Phoenix ICON, 100° FOV · wide-field contact fundus photograph of an infant · 1240x1240:
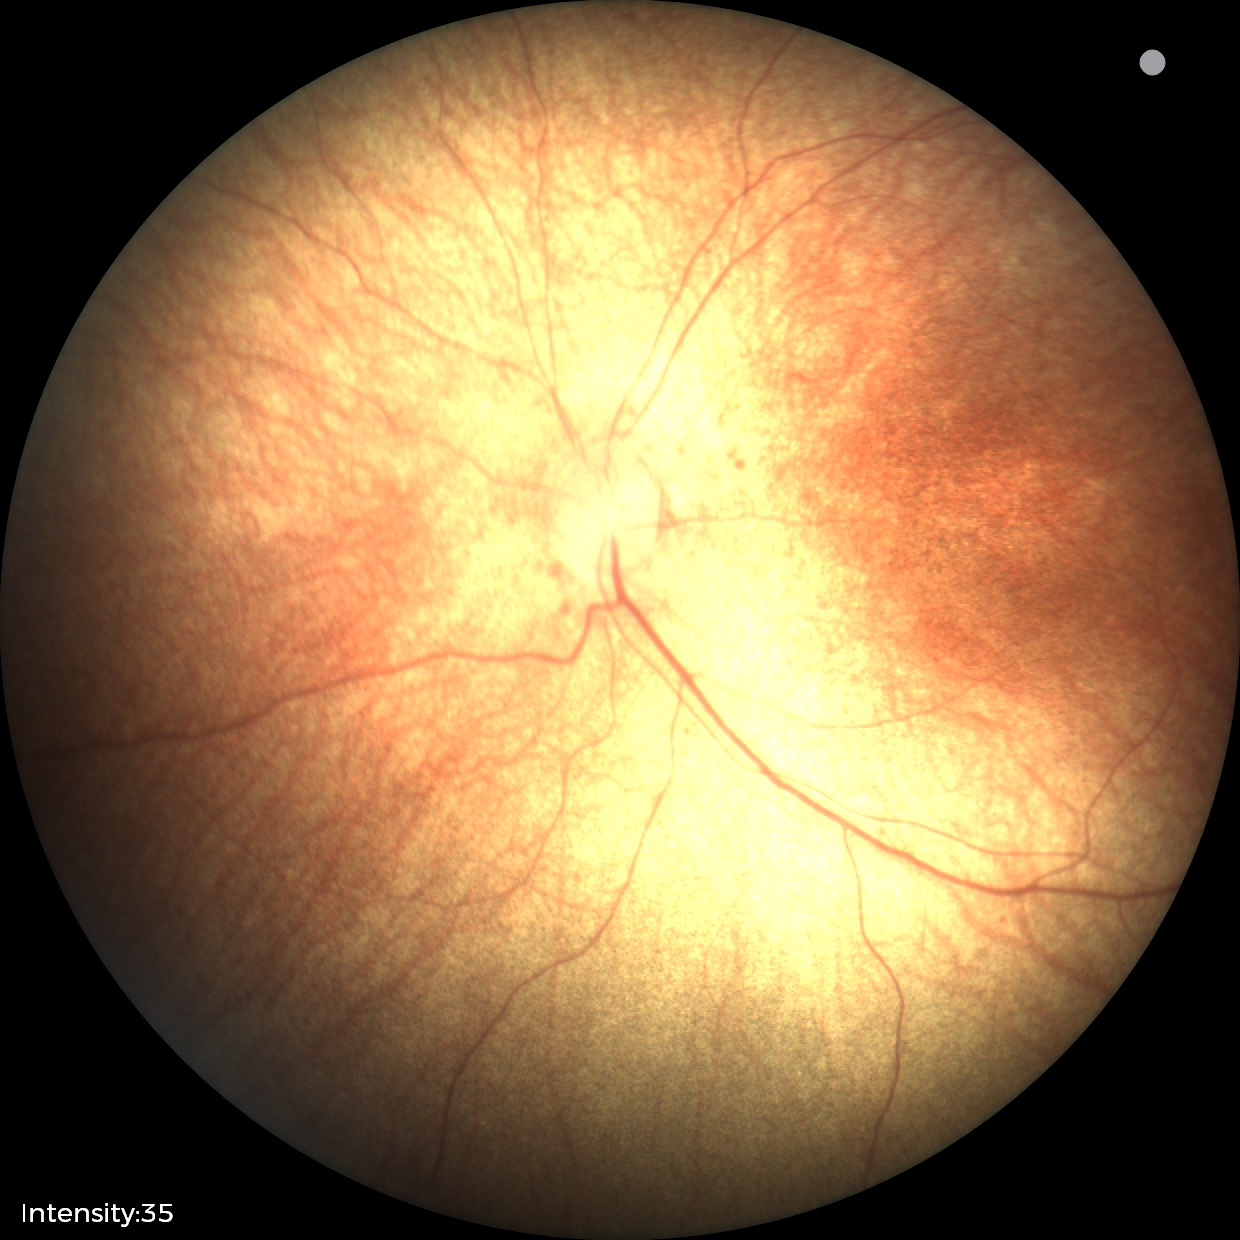 Screening examination diagnosed as physiological.